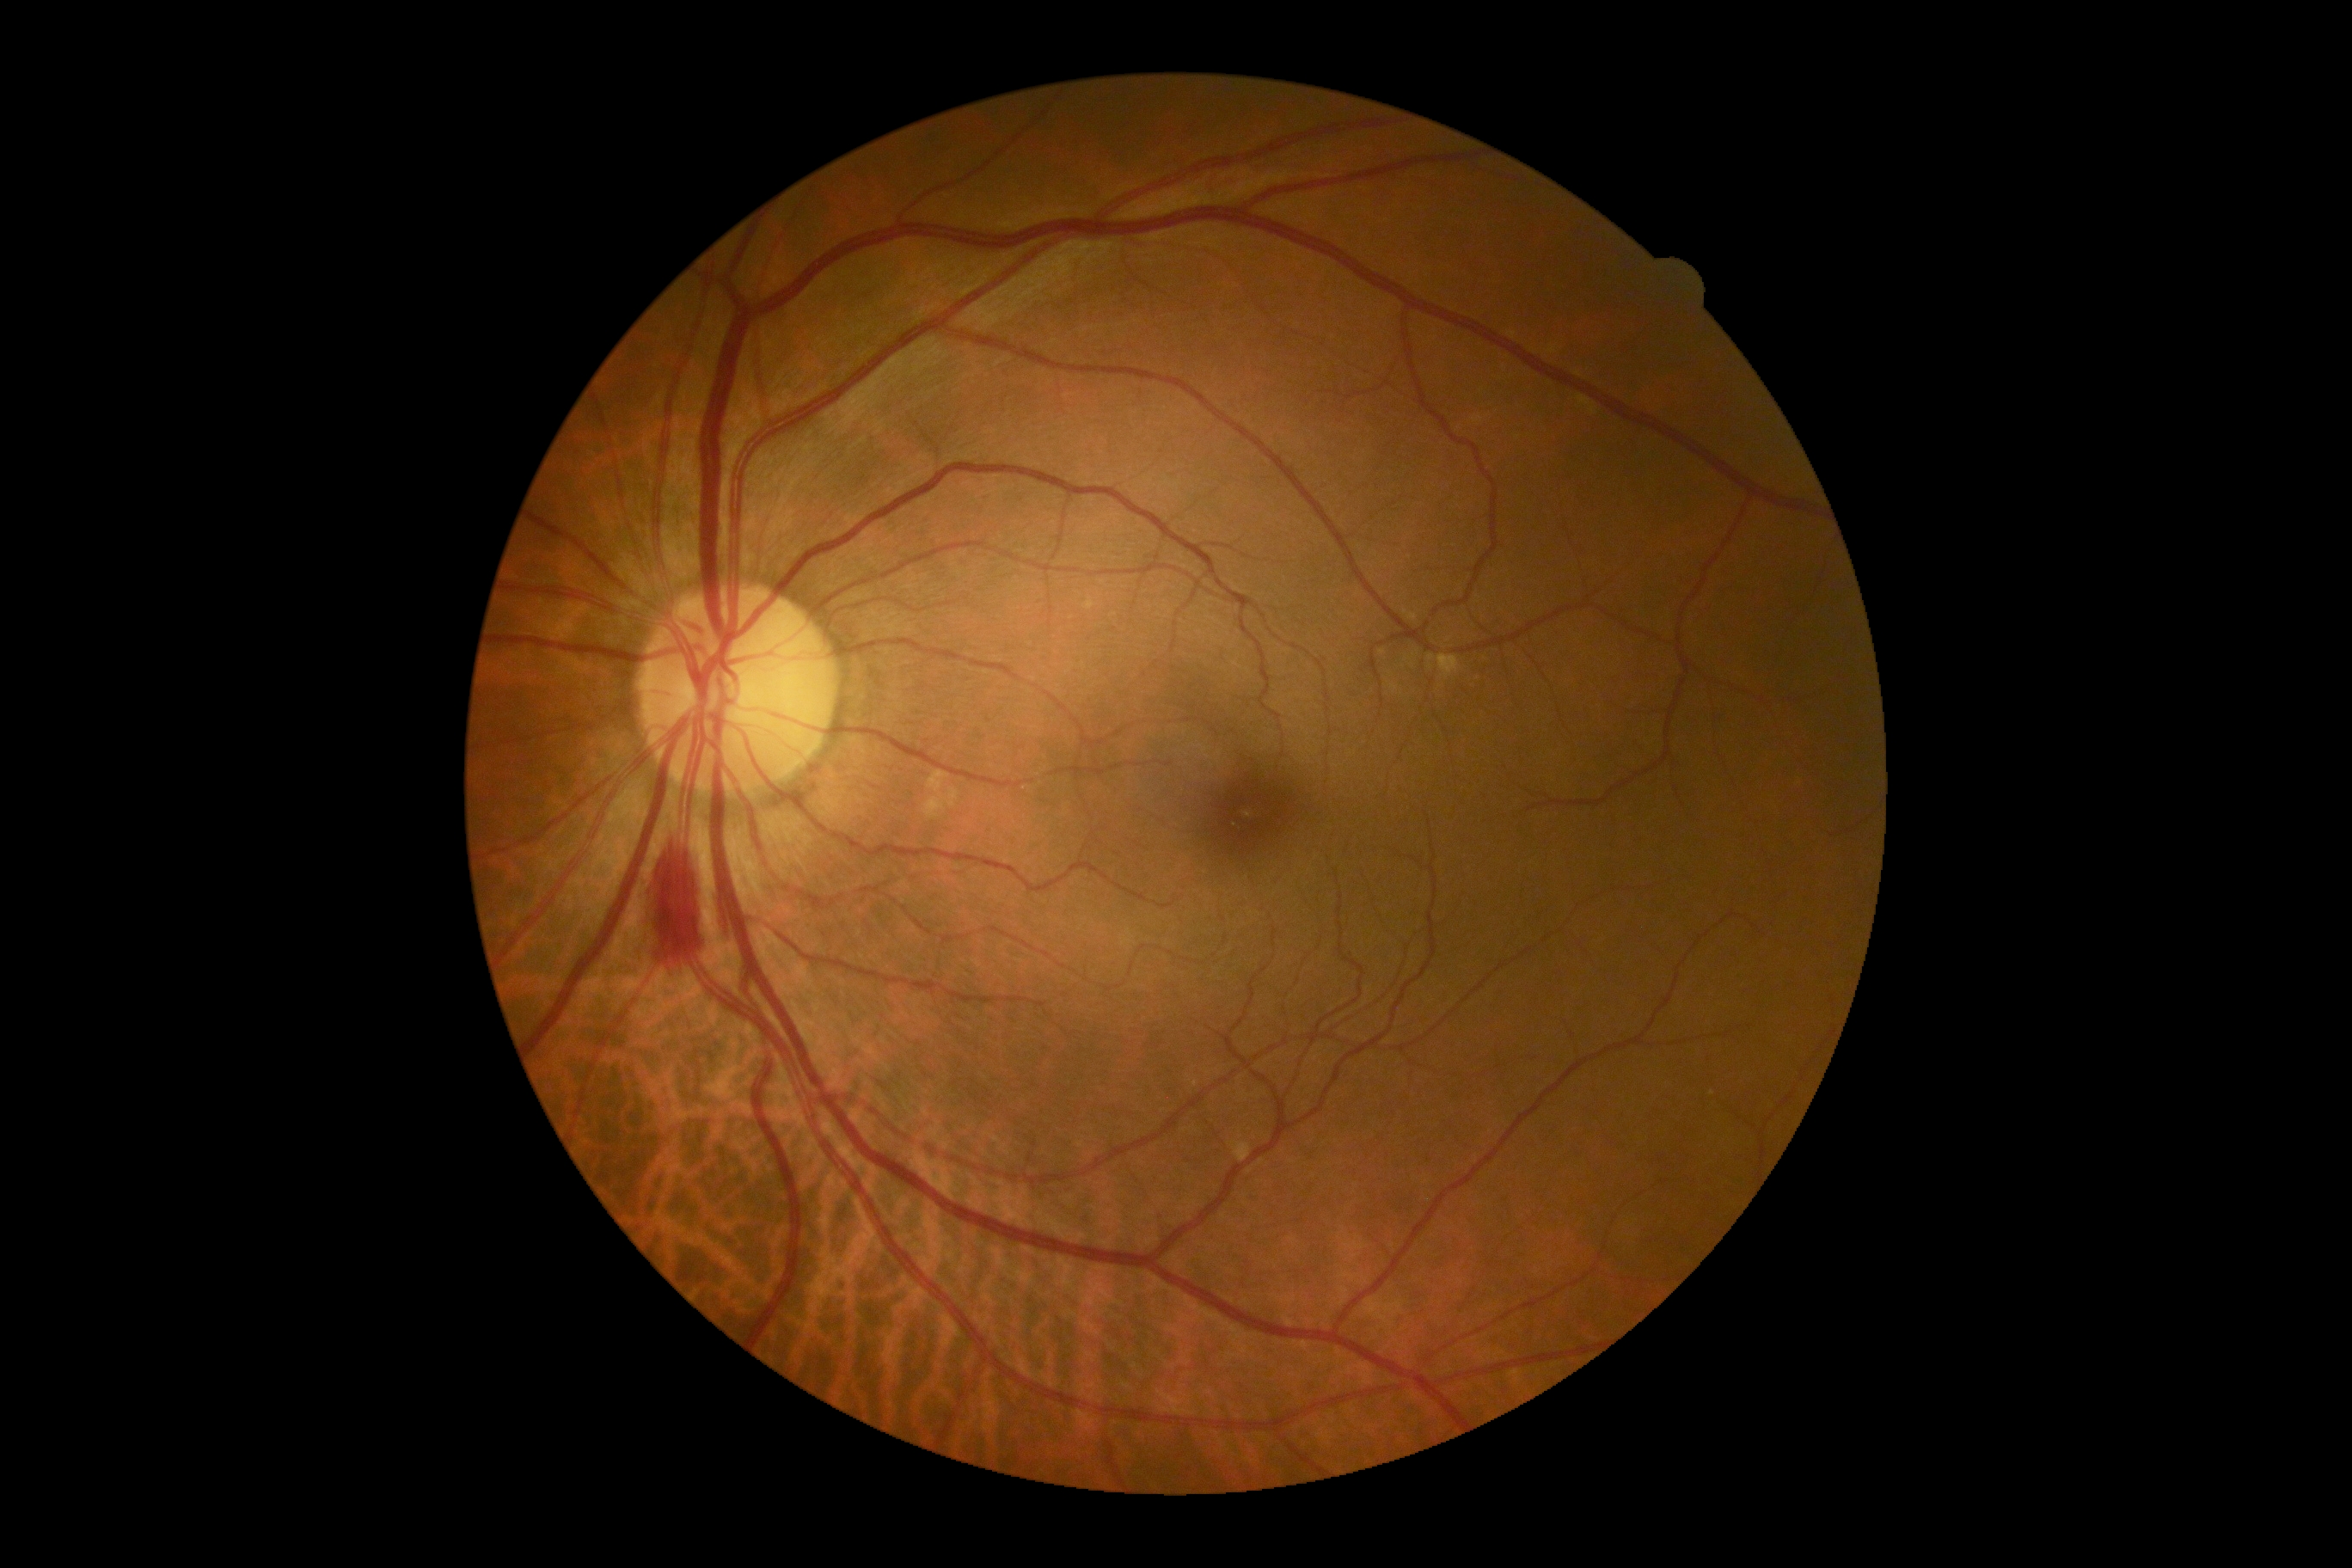 {"dr_category": "non-proliferative diabetic retinopathy", "dr_grade": "2"}